45° FOV. Color fundus photograph.
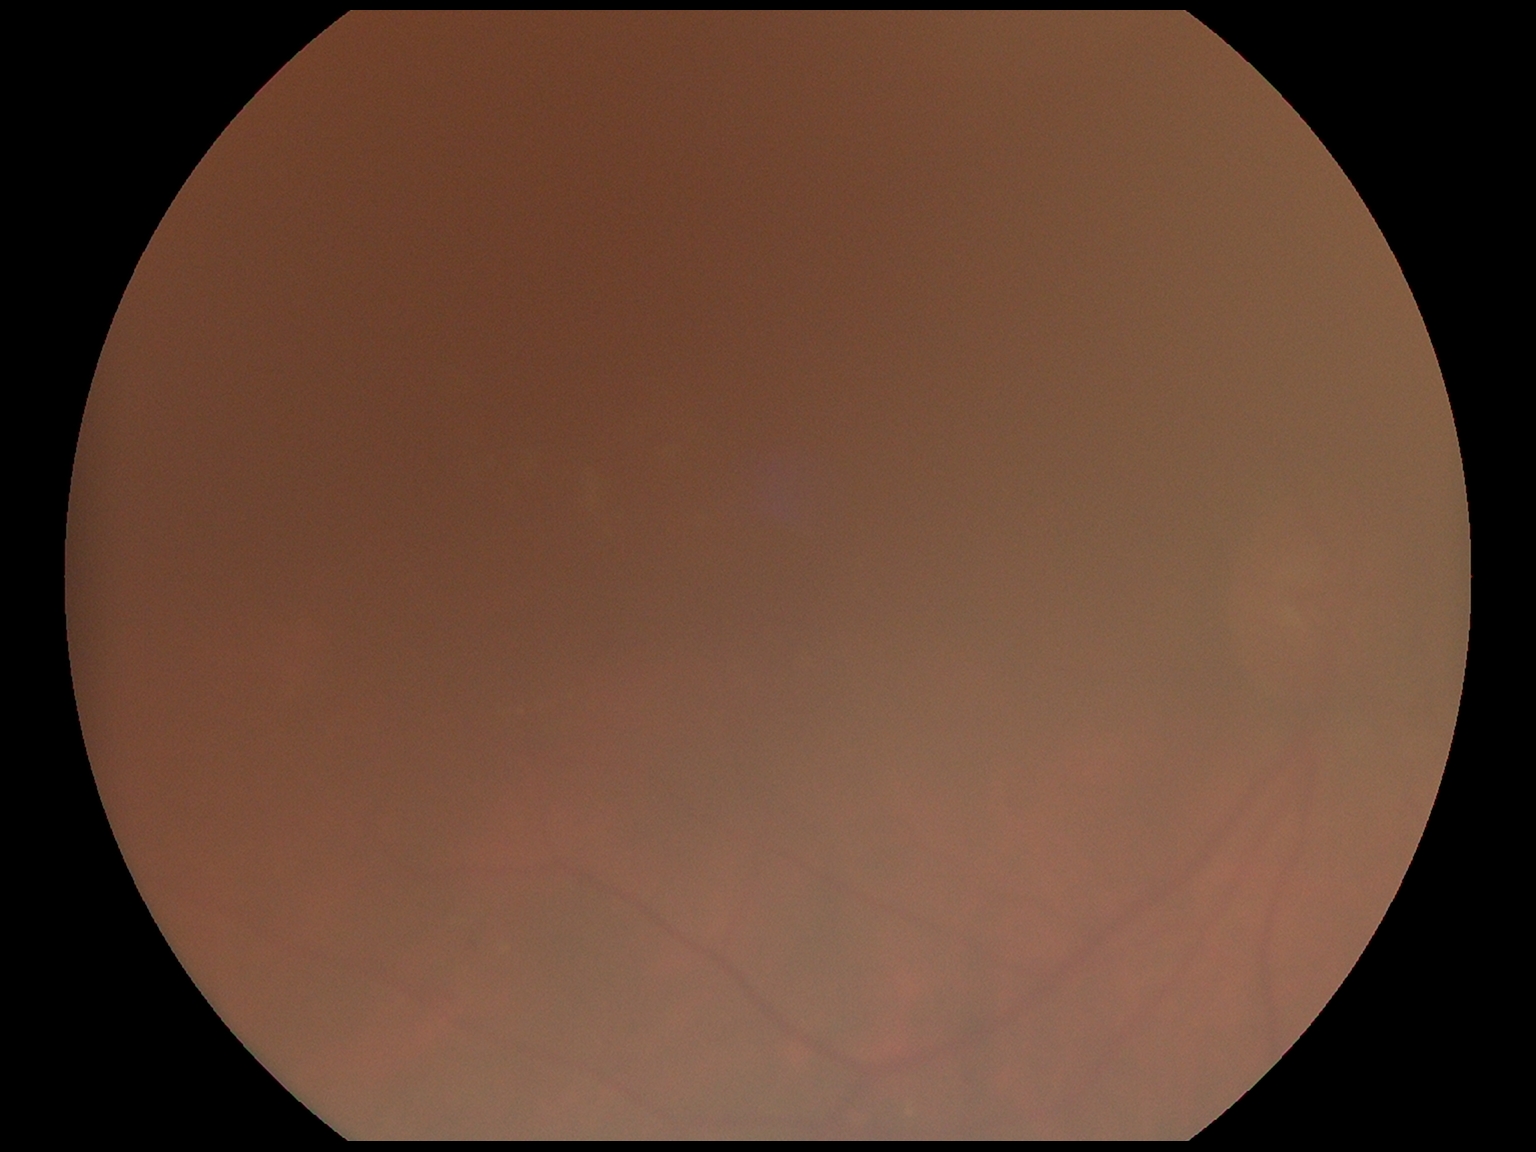
DR: ungradable.